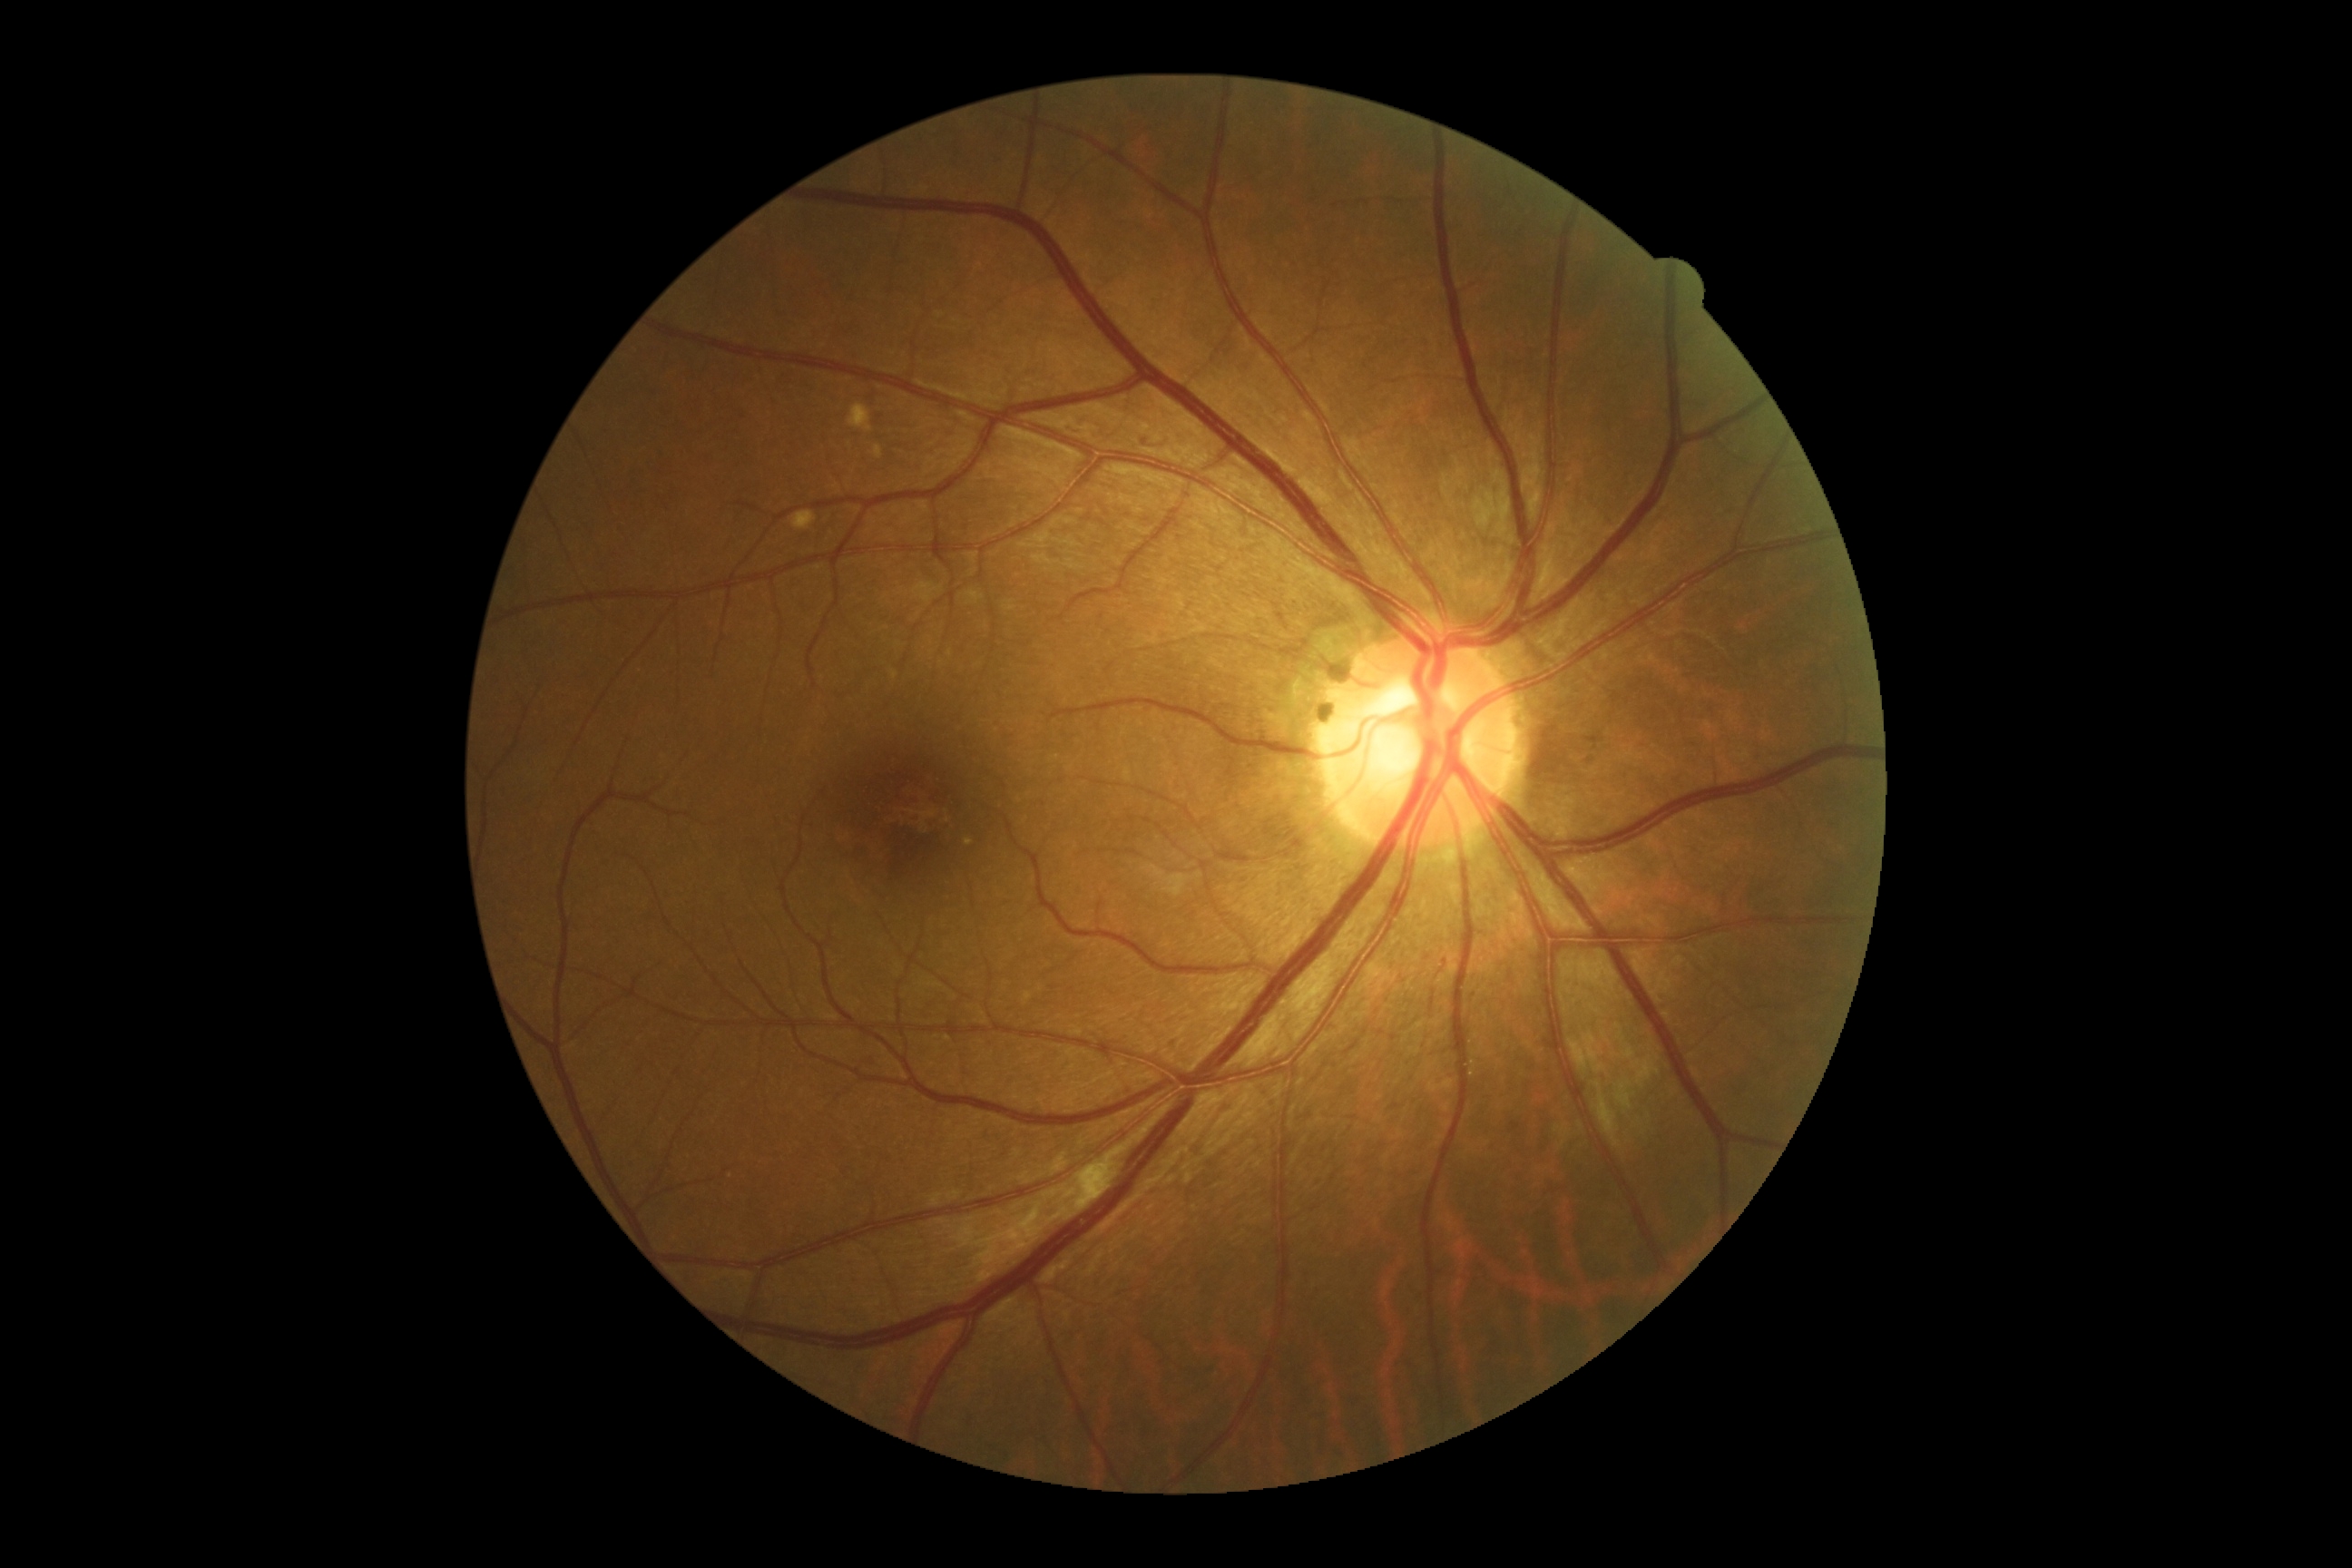
DR stage = 2/4